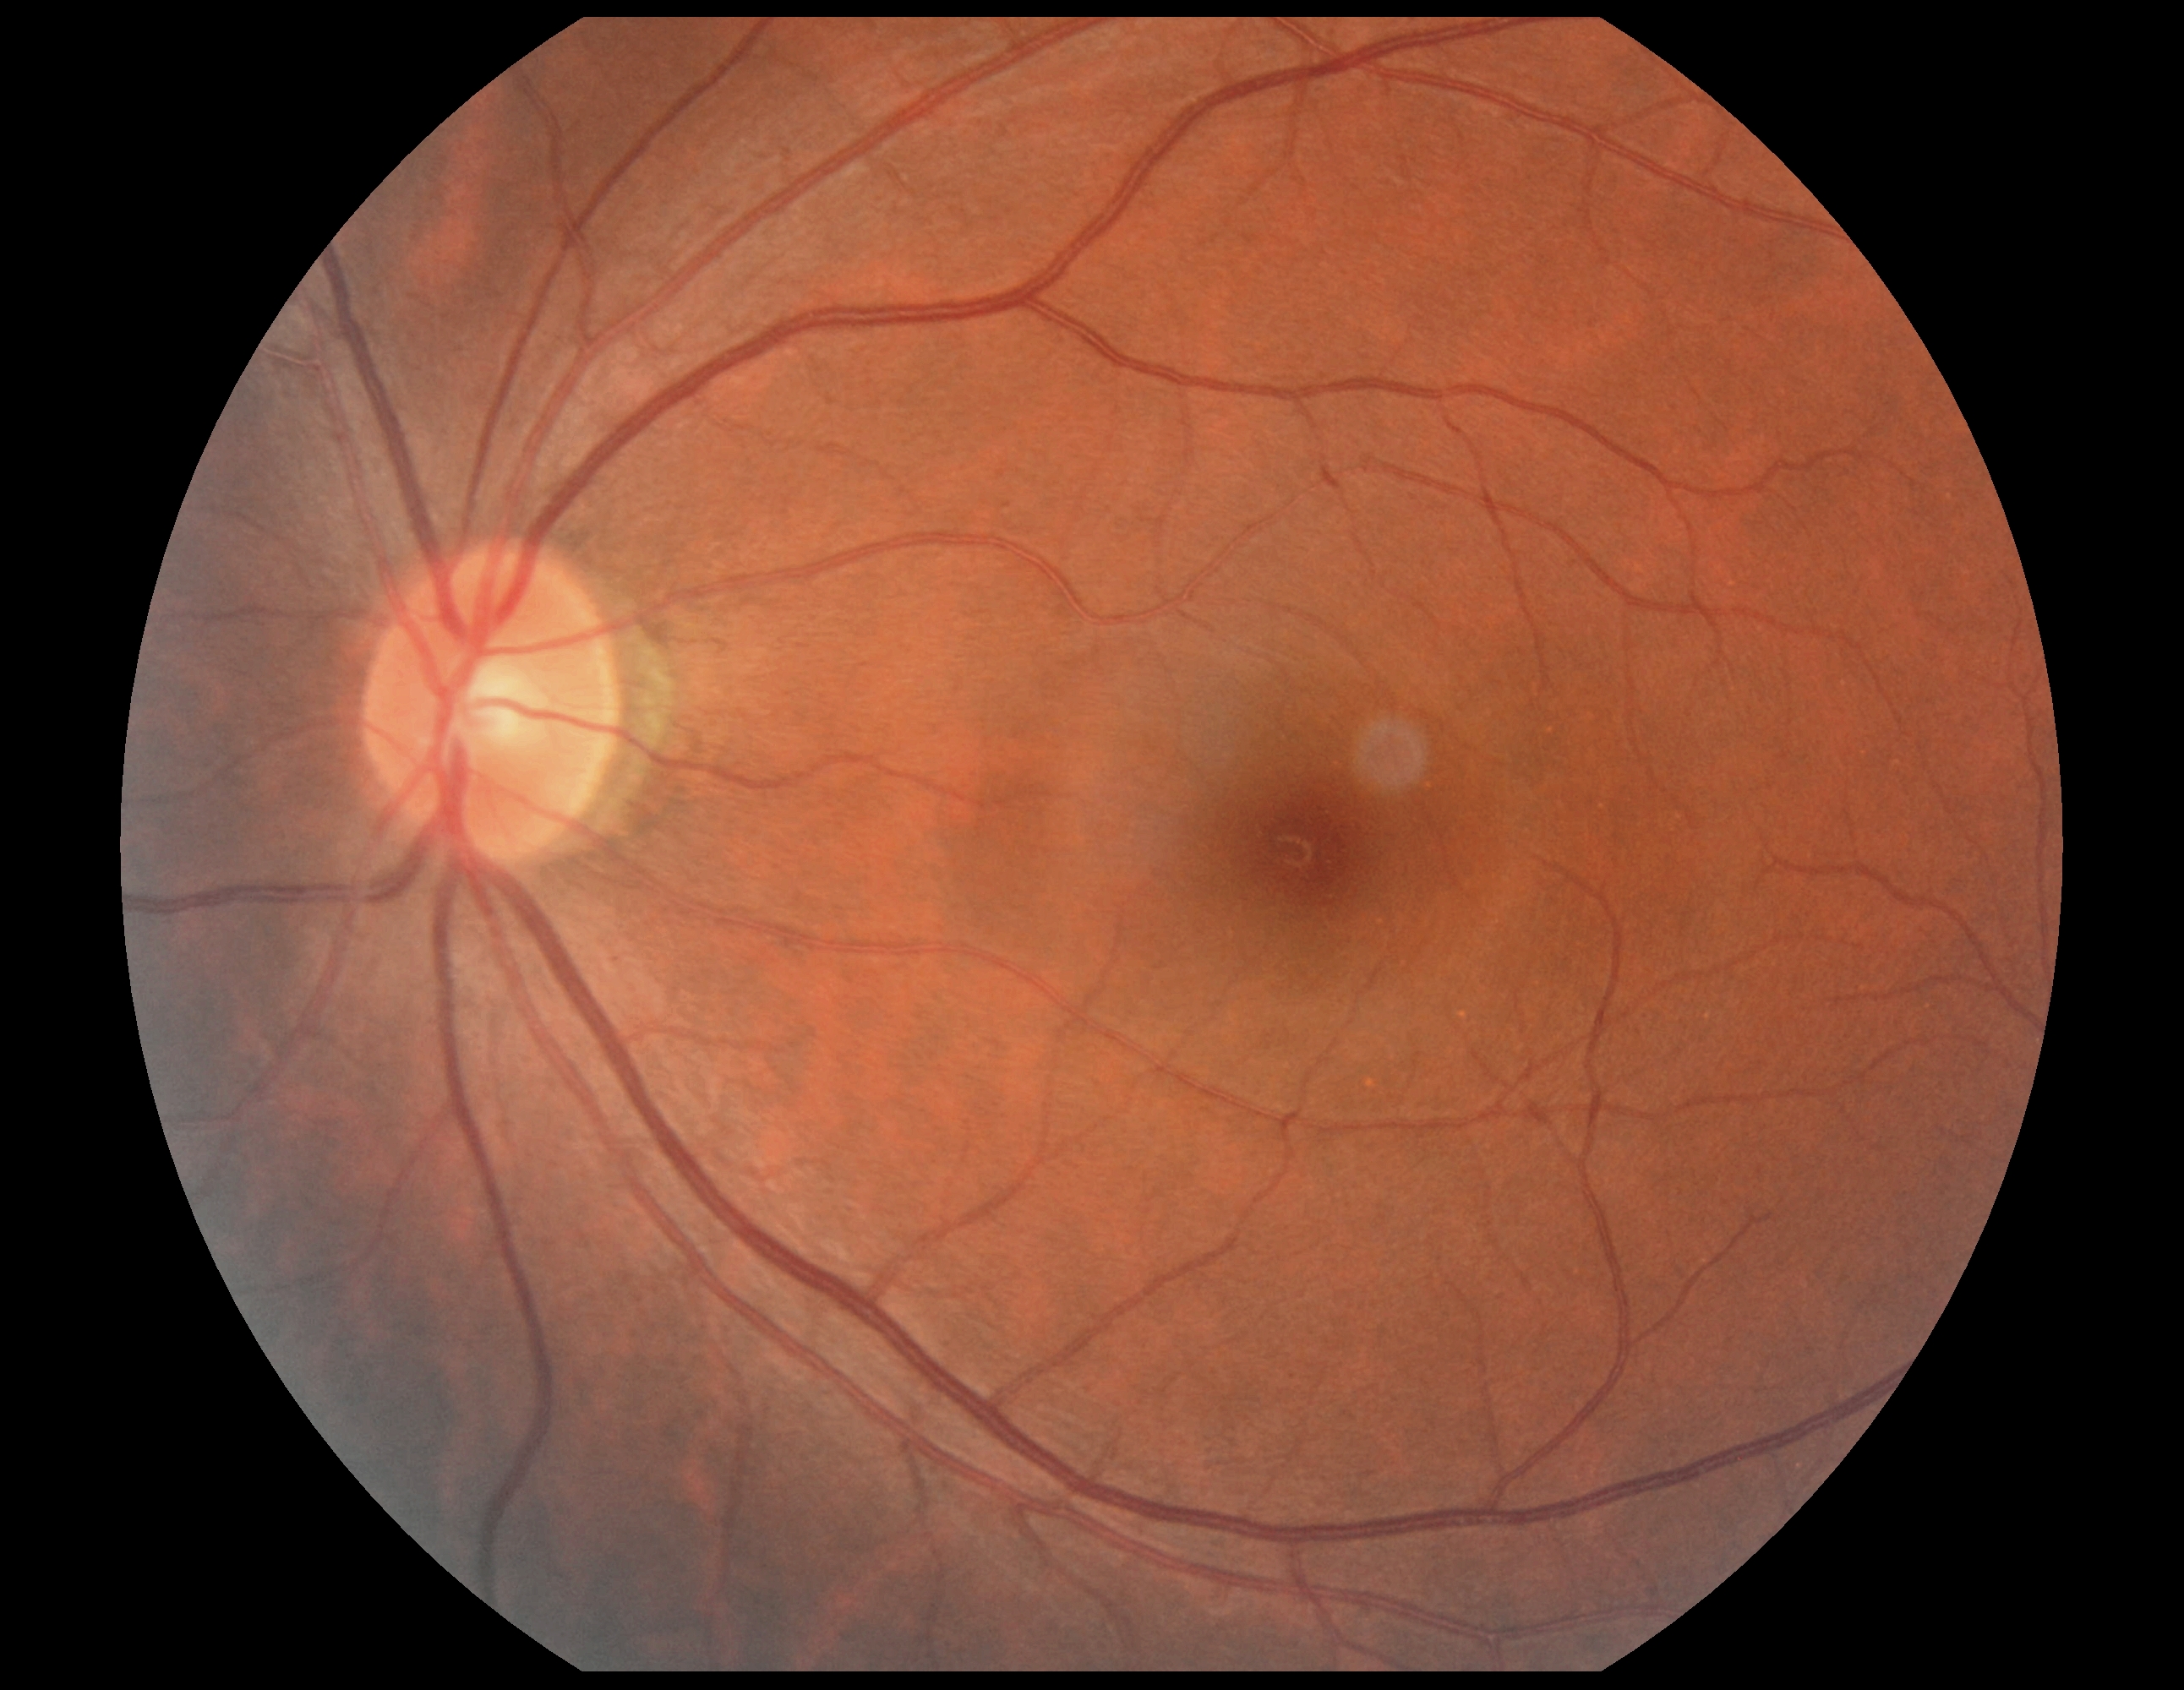
Diabetic retinopathy (DR) is grade 0.